No pharmacologic dilation · 848x848 · camera: NIDEK AFC-230 · DR severity per modified Davis staging · fundus photo — 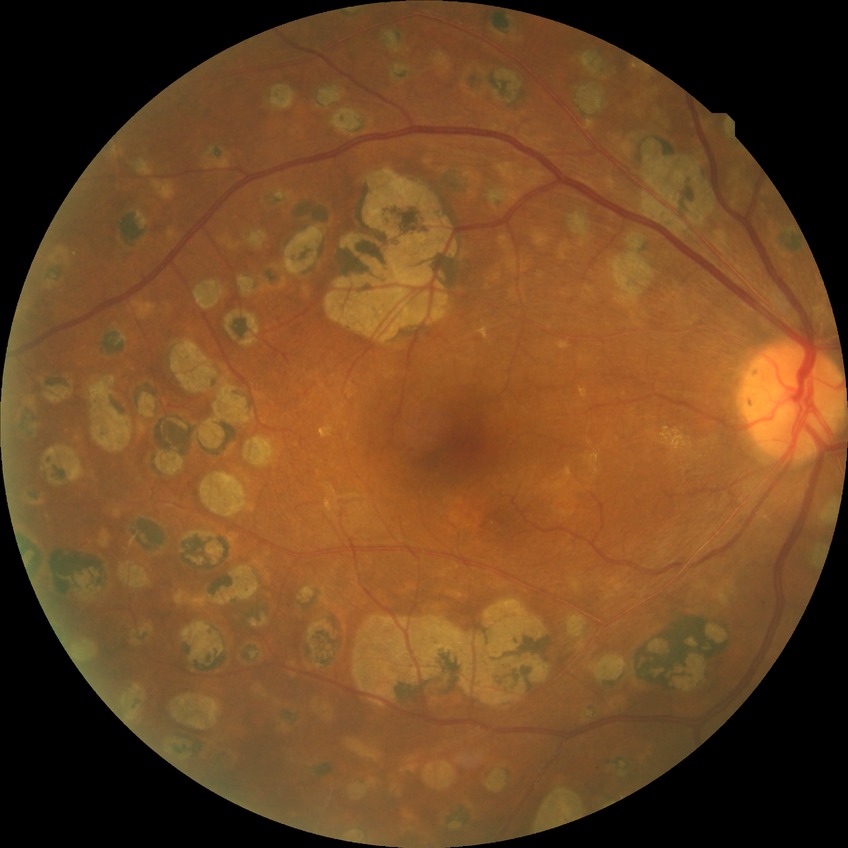

Diabetic retinopathy severity: proliferative diabetic retinopathy.